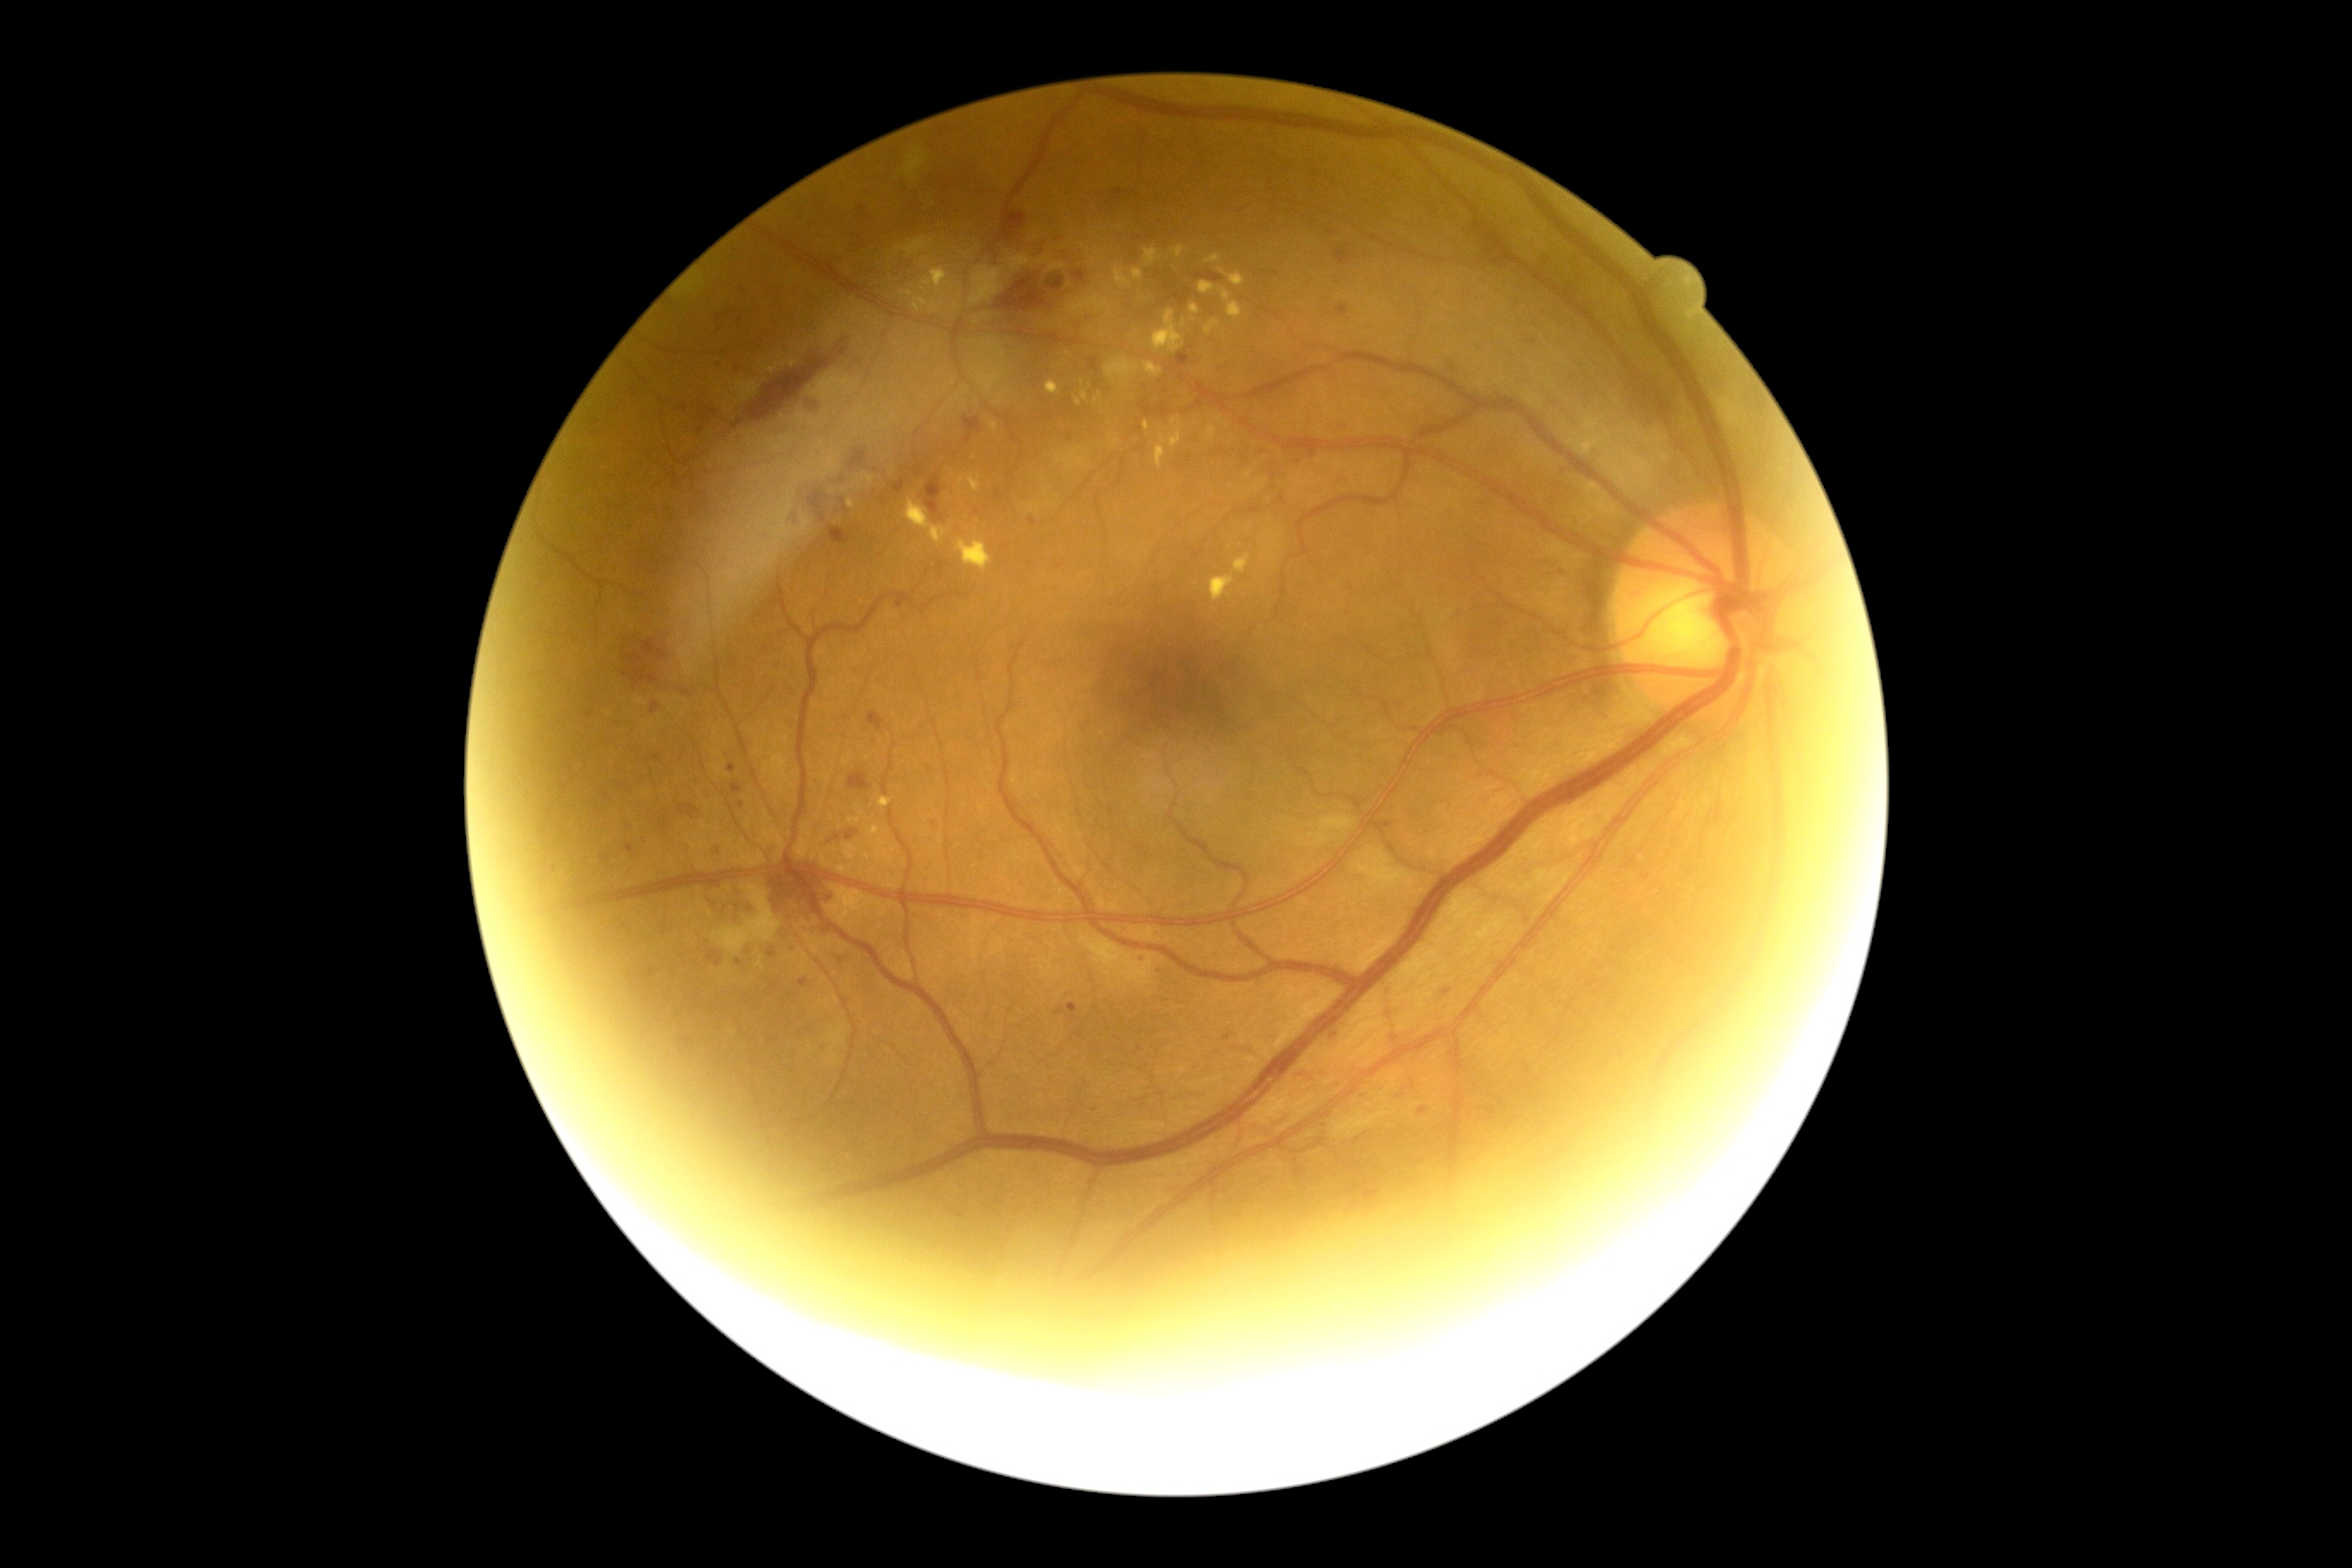

Retinopathy grade is 2.